Infant wide-field fundus photograph: 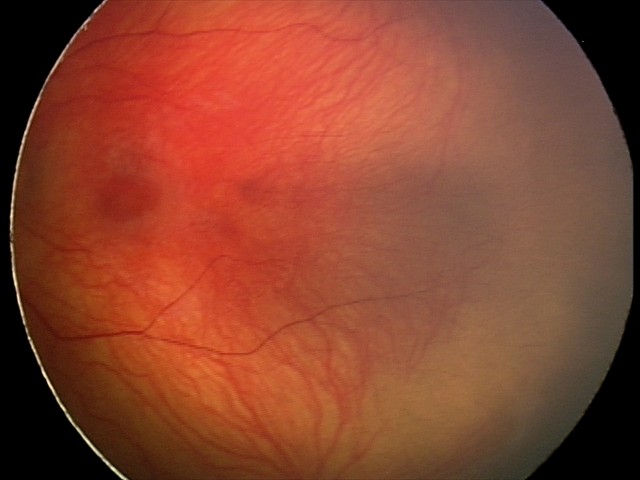 Series diagnosed as status post ROP.
Without plus disease.